848 by 848 pixels.
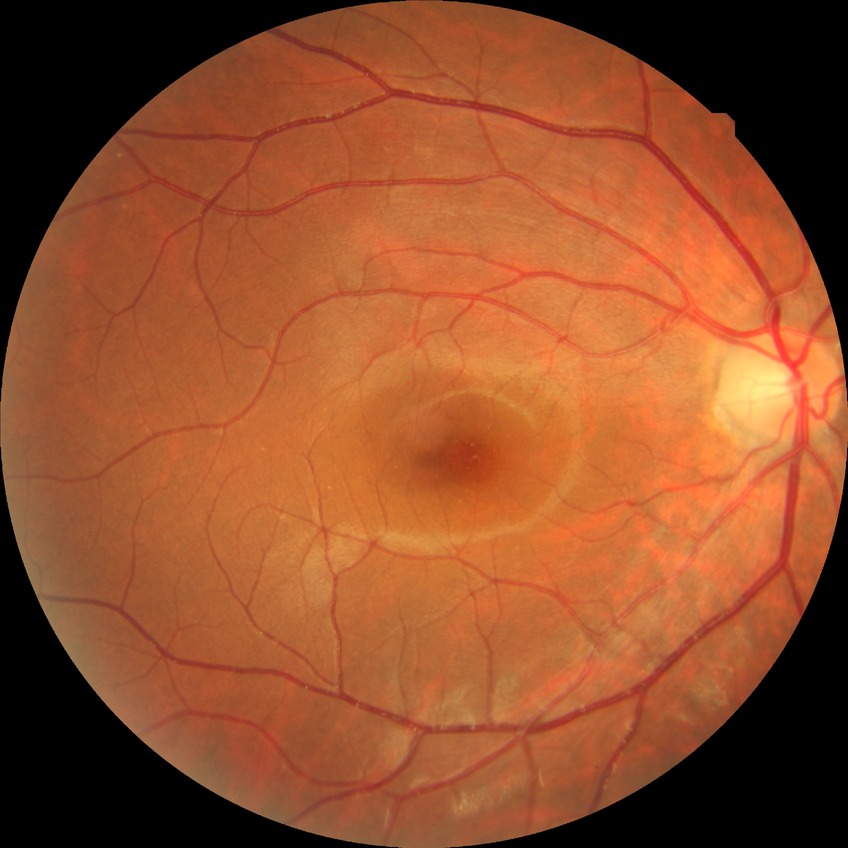 diabetic retinopathy severity: no diabetic retinopathy.